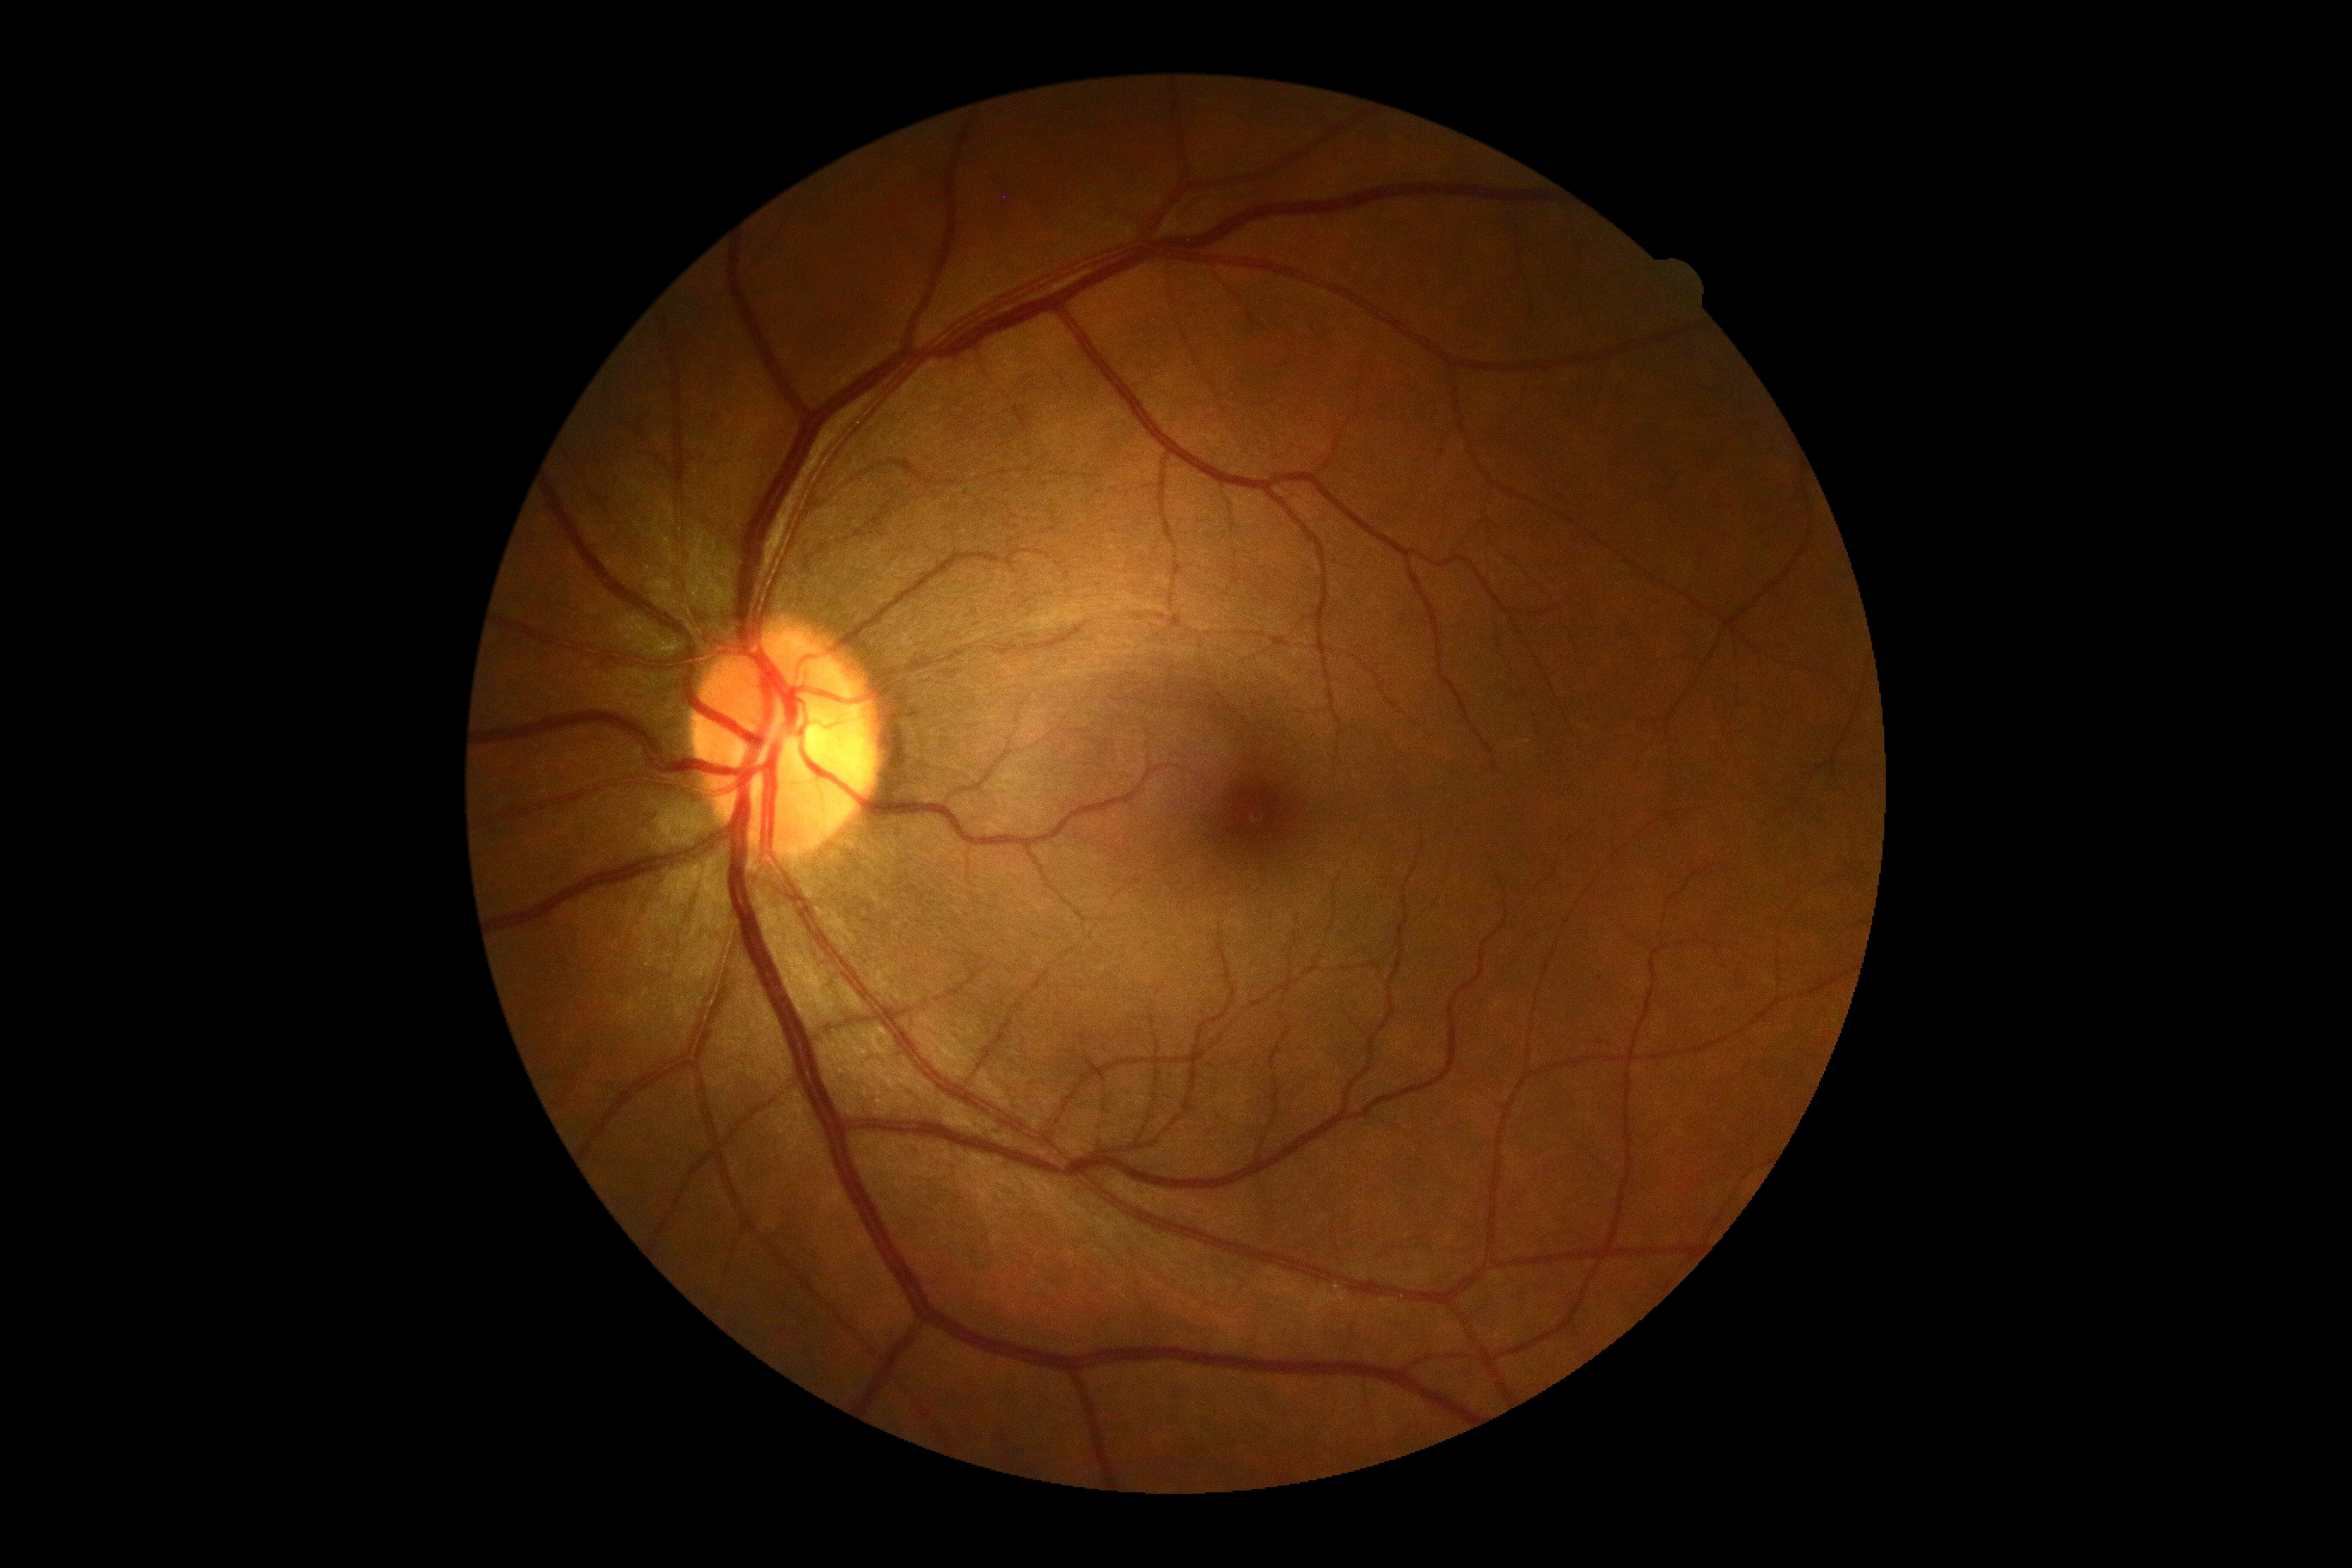 DR impression@no apparent DR; DR stage@0.